2040x1820px: 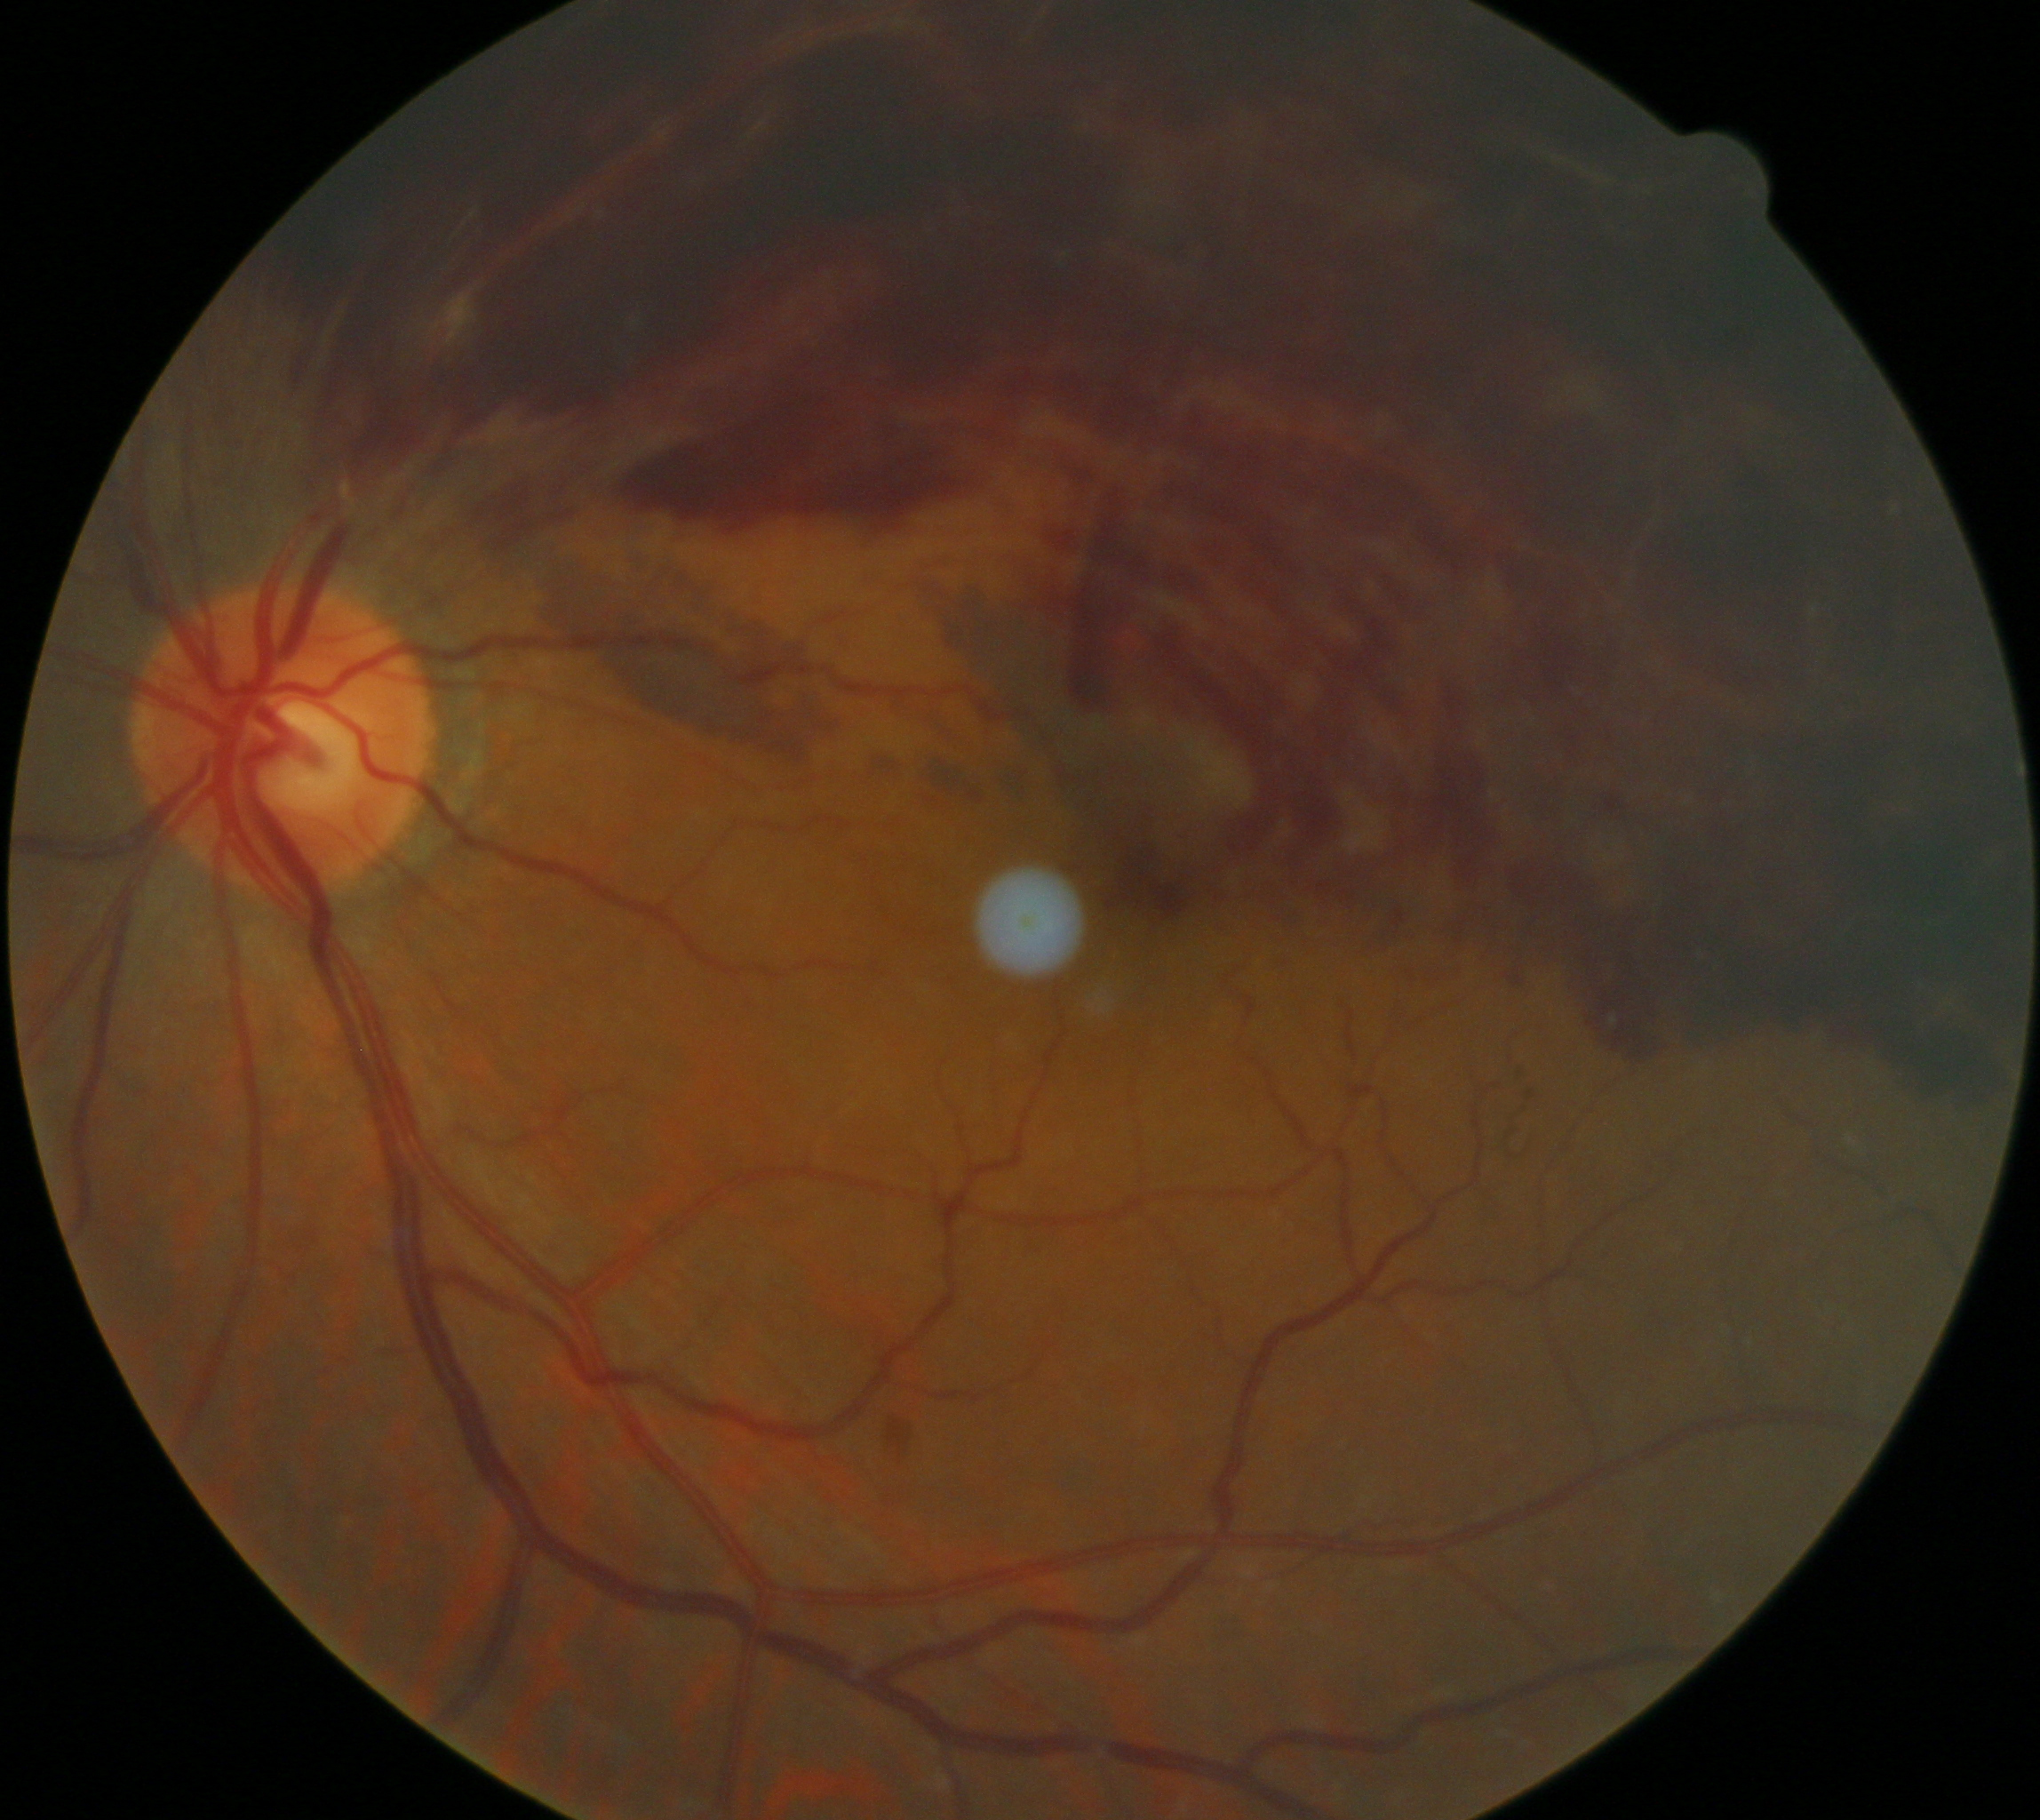 DR grade: PDR (4) — neovascularization and/or vitreous/pre-retinal hemorrhage.